CFP. Nonmydriatic — 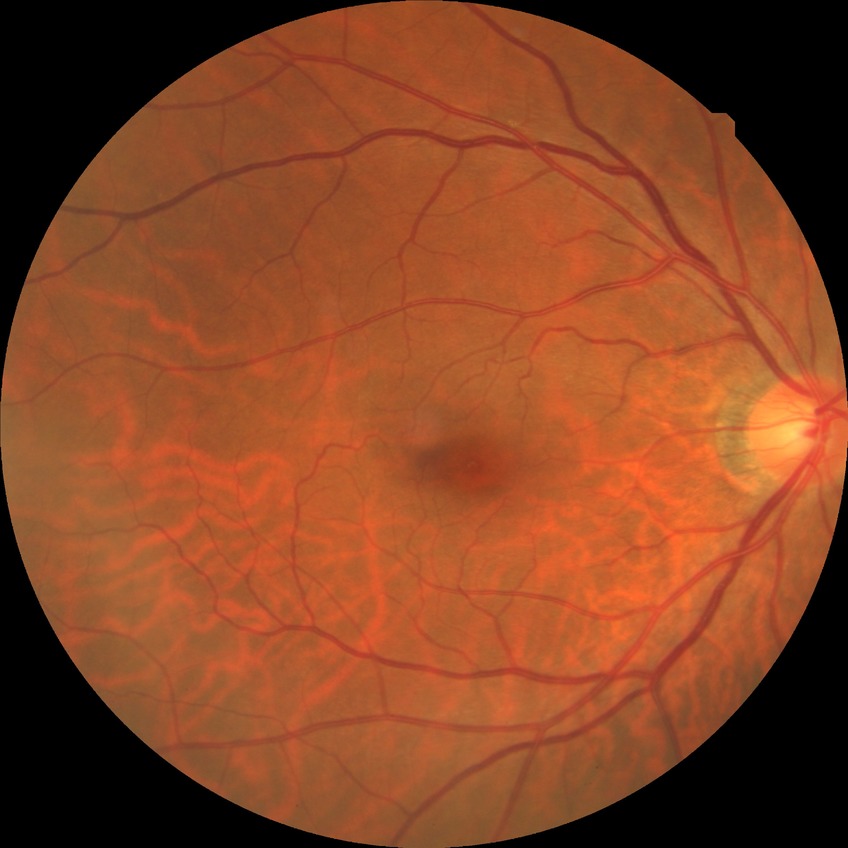

Assessment:
* retinopathy grade — no diabetic retinopathy